848 by 848 pixels: 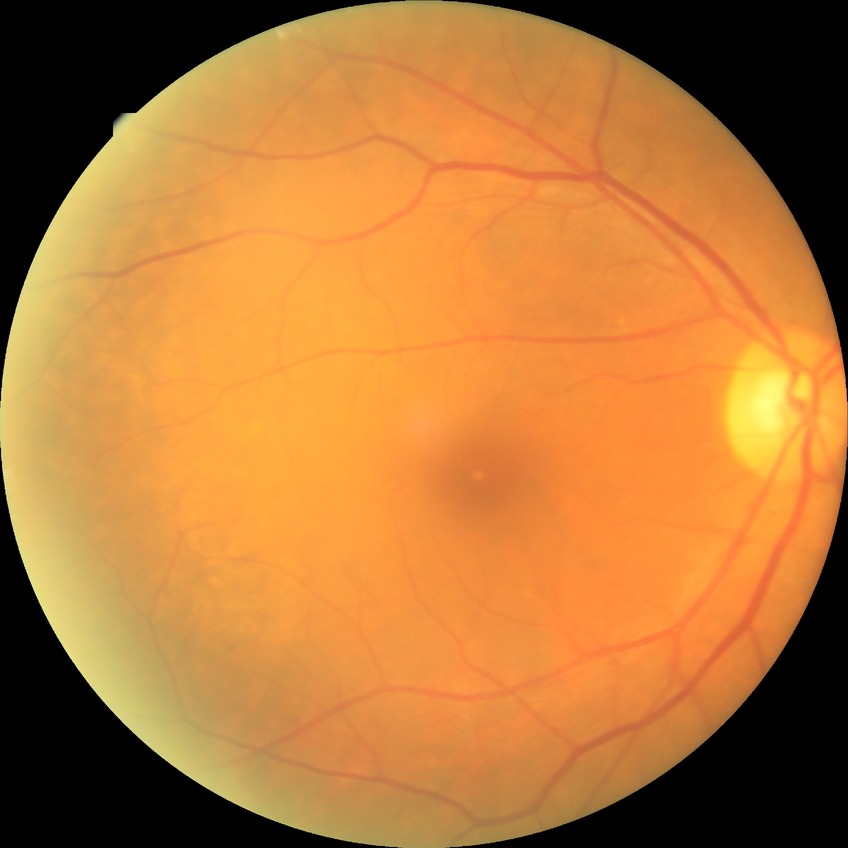

Modified Davis classification is simple diabetic retinopathy. The retinopathy is classified as non-proliferative diabetic retinopathy.